Retinal fundus photograph
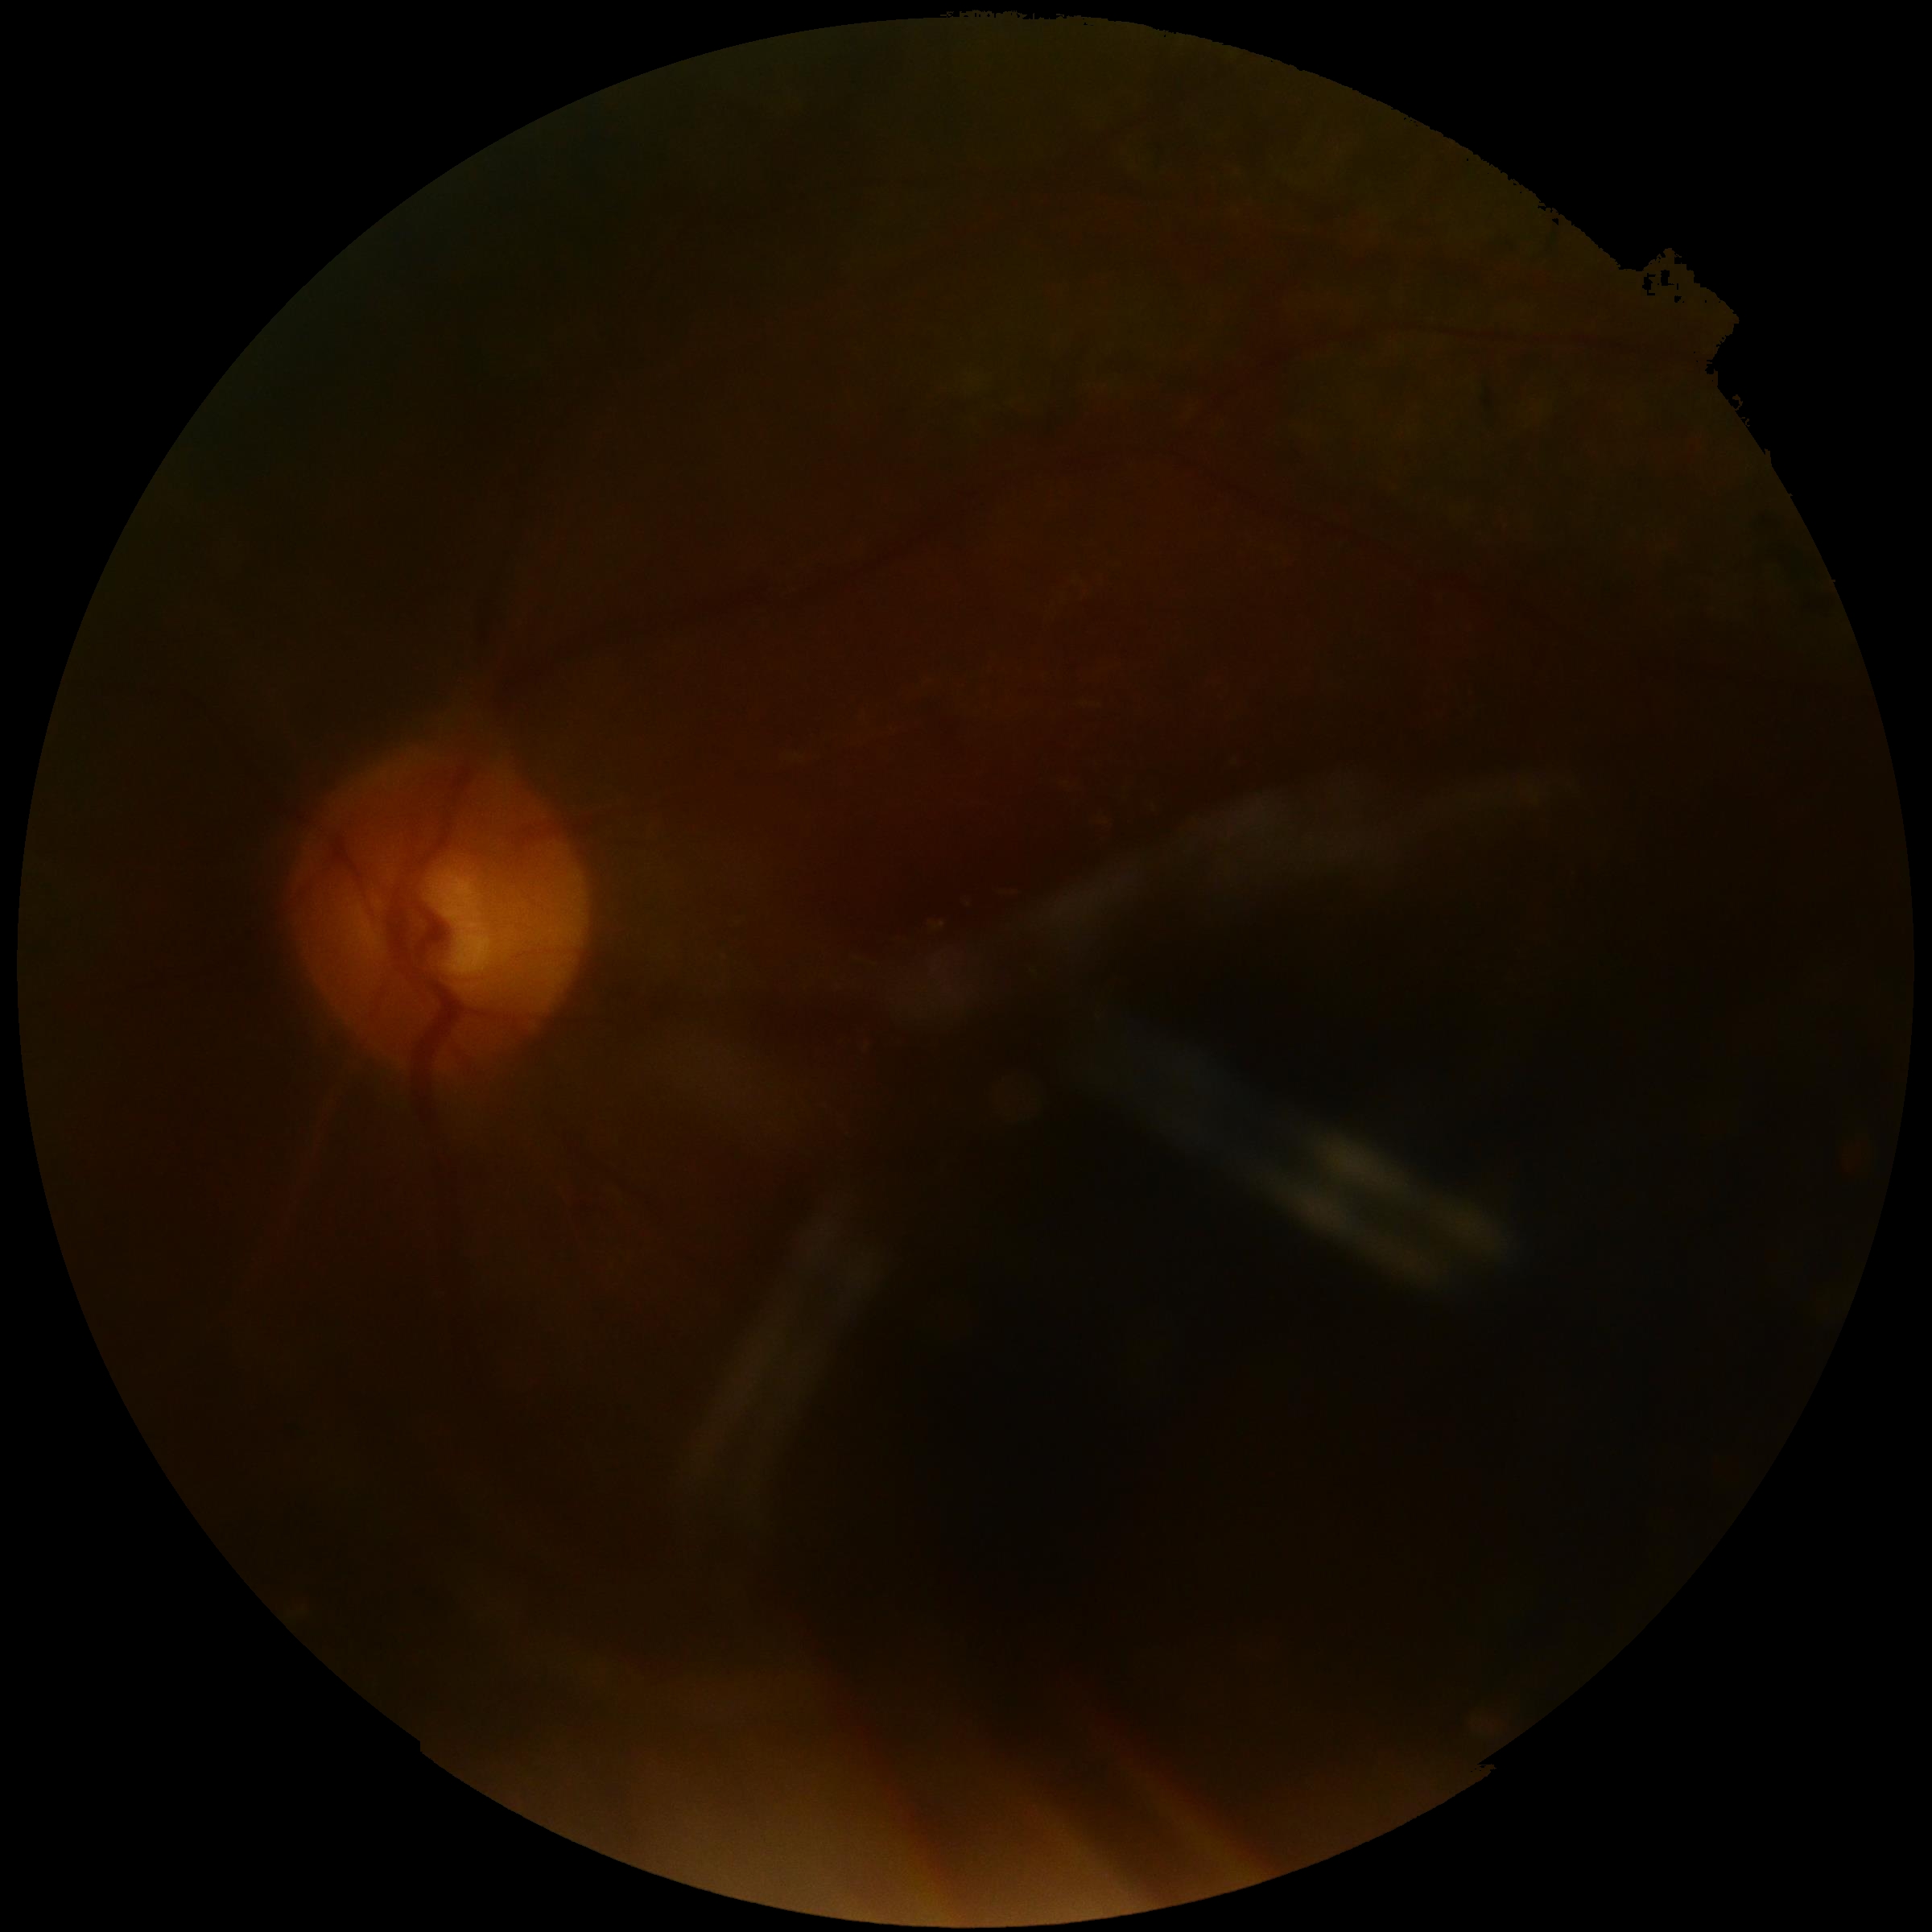 image quality: insufficient for DR assessment, diabetic retinopathy (DR): ungradable due to poor image quality.